Infant wide-field fundus photograph · 640x480 — 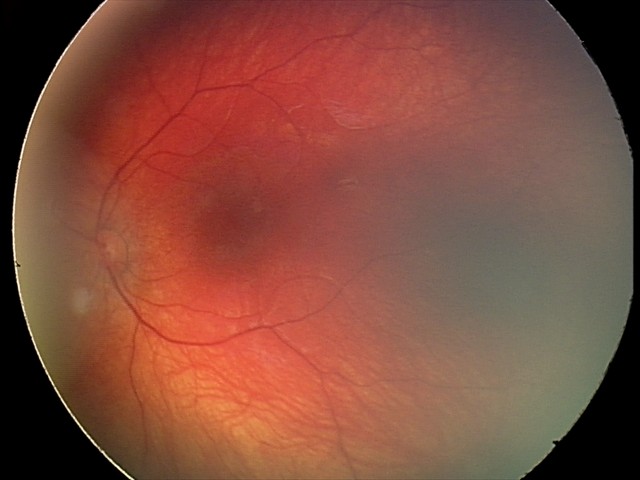

Screening series with retinal hemorrhages.